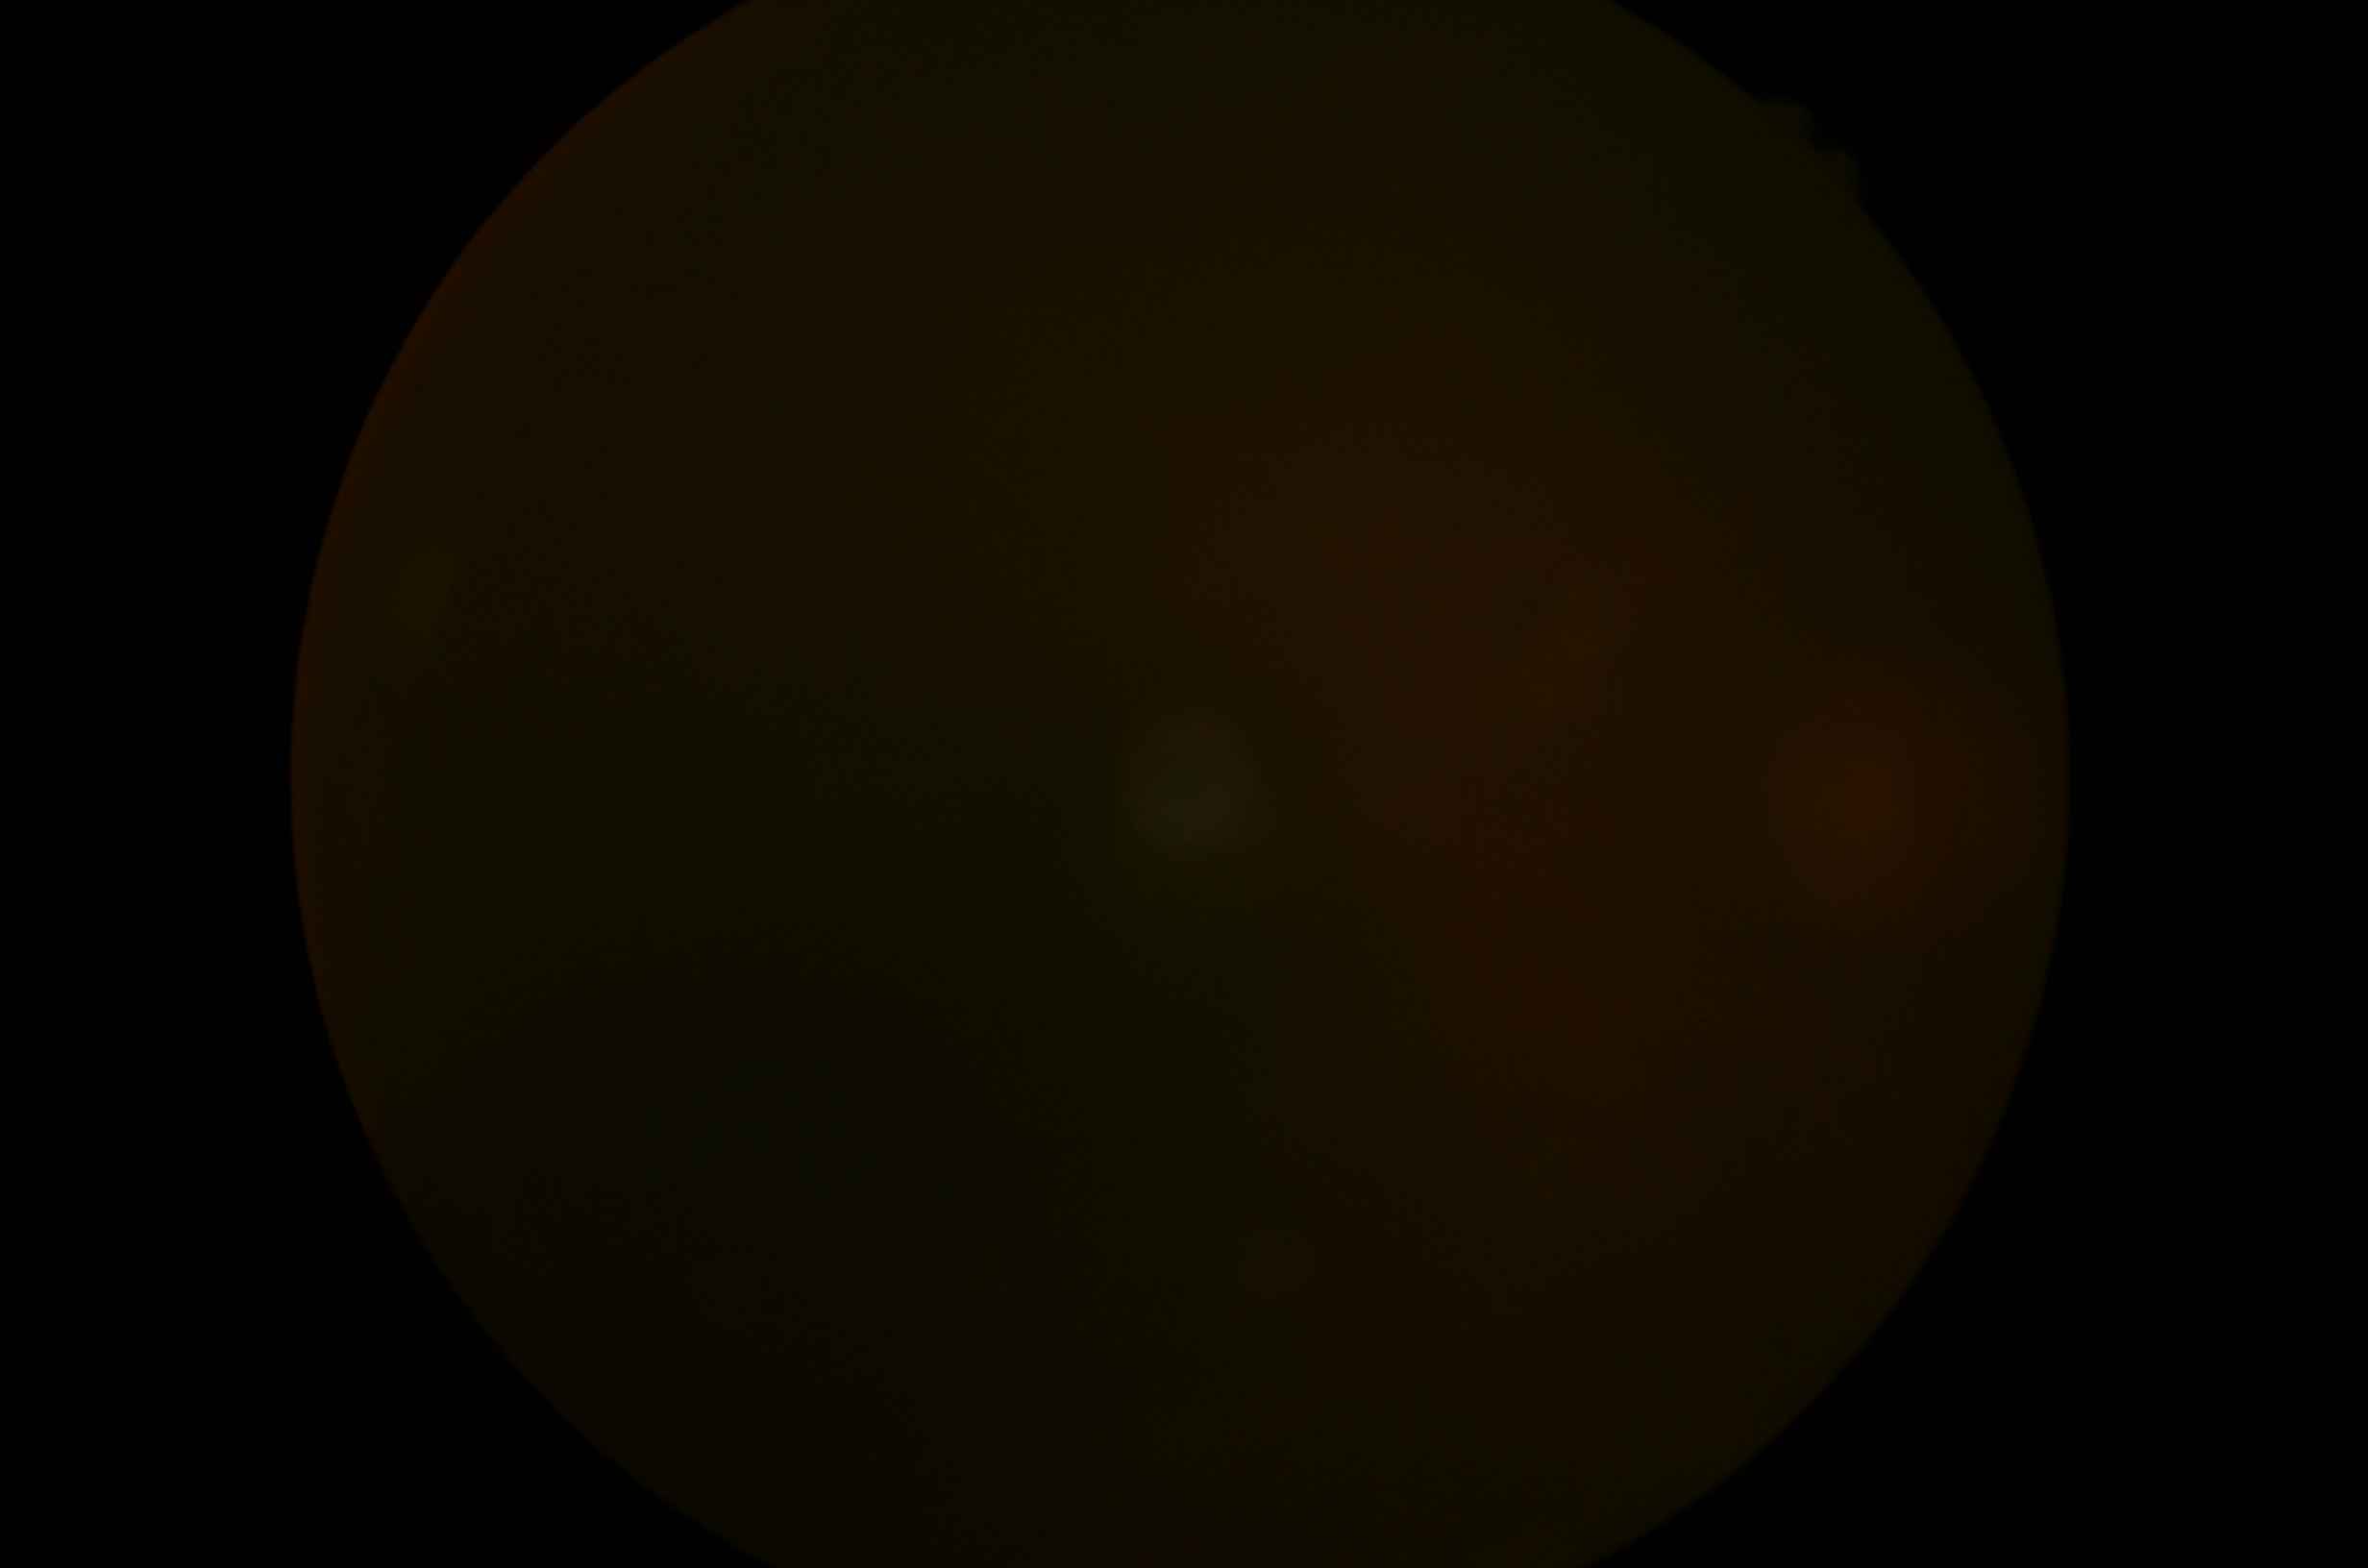
DR severity is ungradable. Image quality is insufficient for diabetic retinopathy assessment.